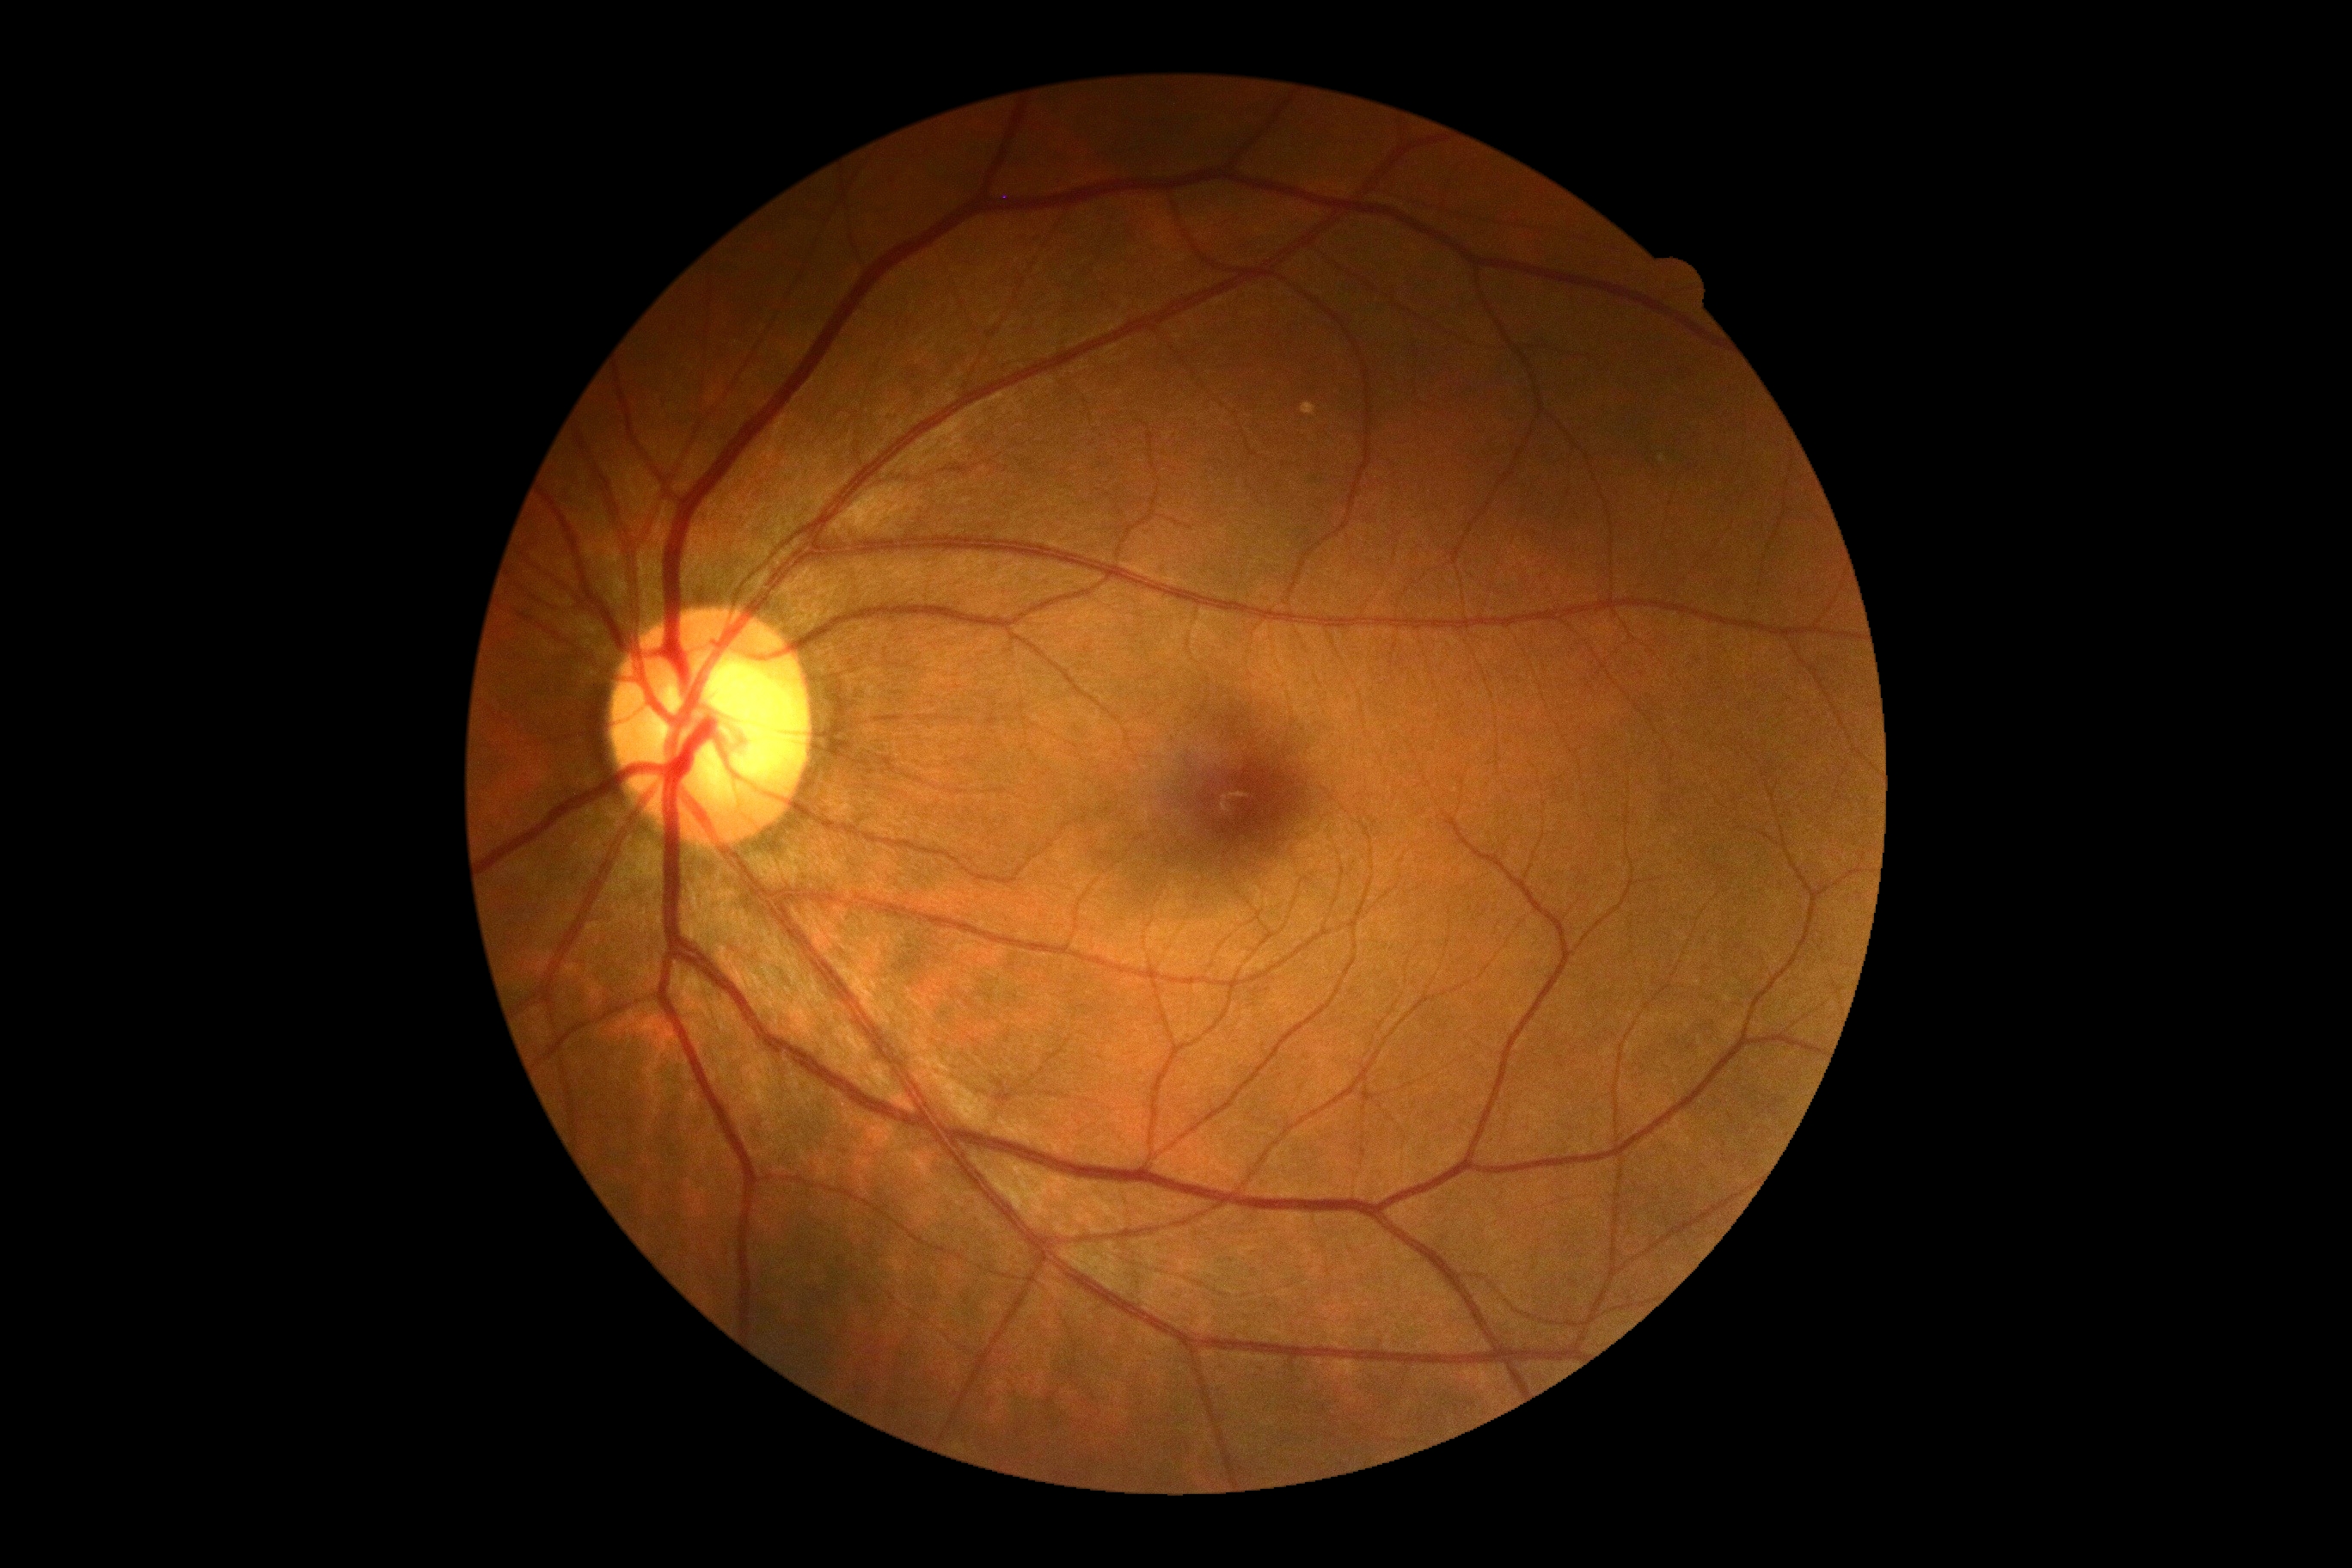
Diabetic retinopathy grade: 0.